DR severity per modified Davis staging
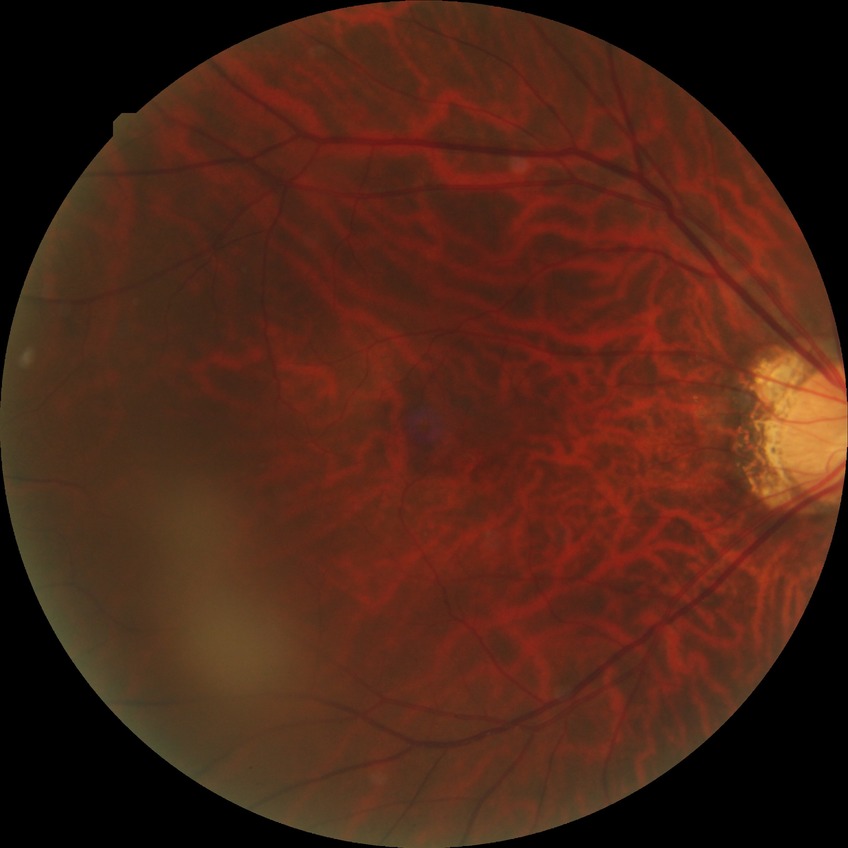
Davis stage: NDR | DR impression: no apparent DR.